Phoenix ICON wide-field infant fundus image; 100° field of view (Phoenix ICON)
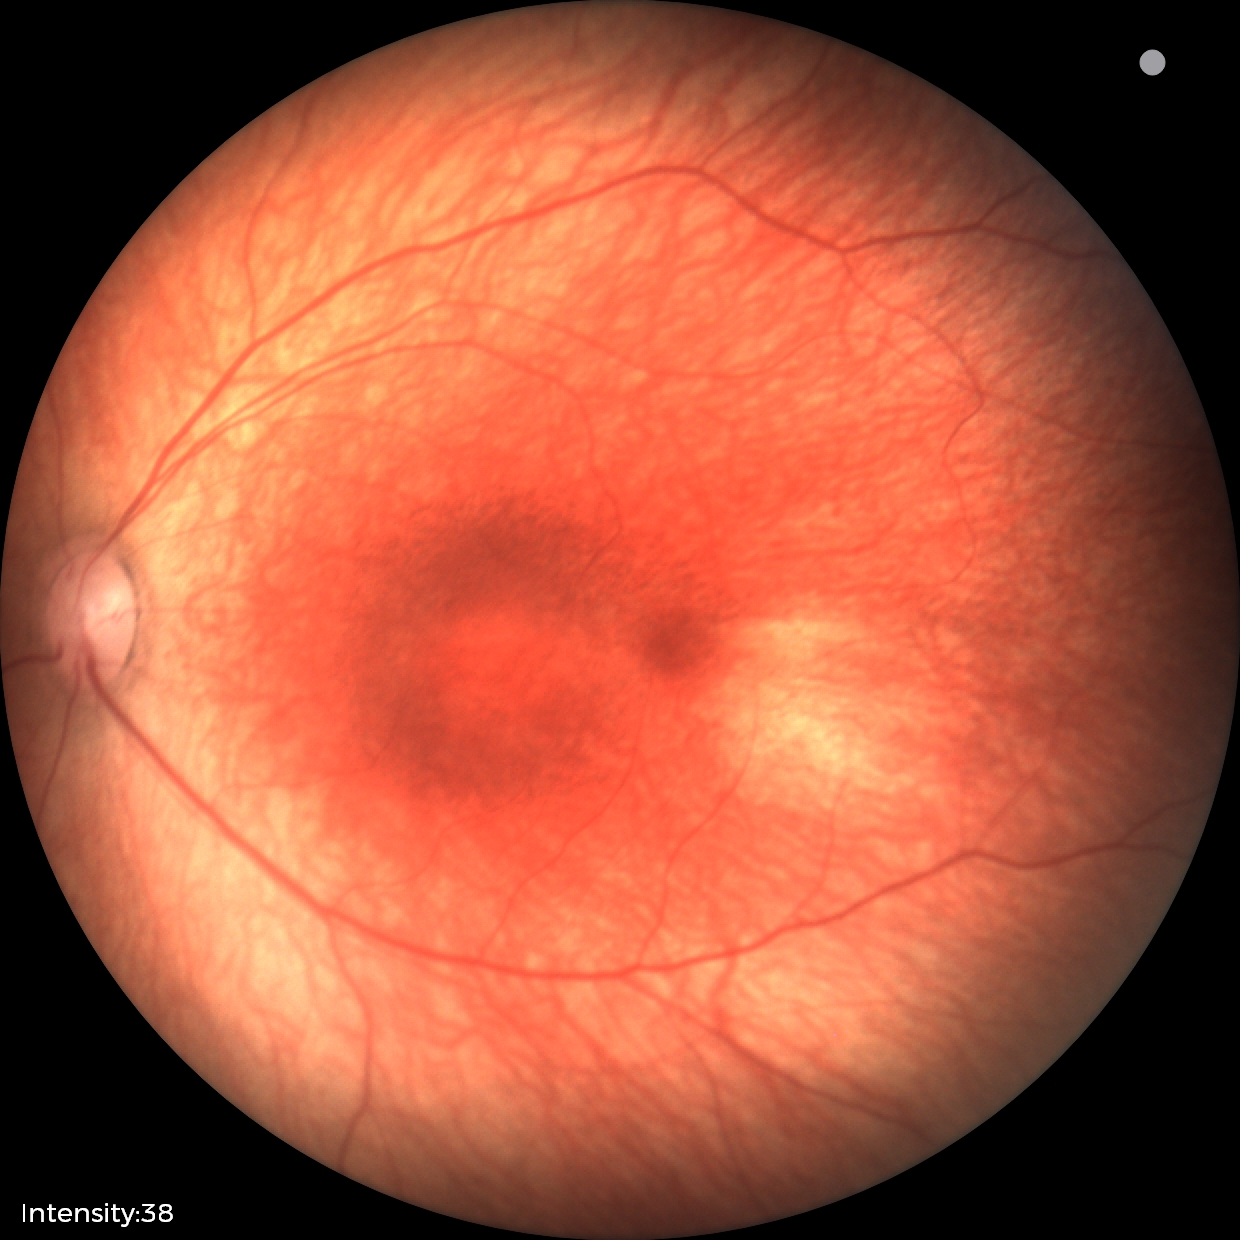
No retinal pathology identified on screening.